Nonmydriatic fundus photograph
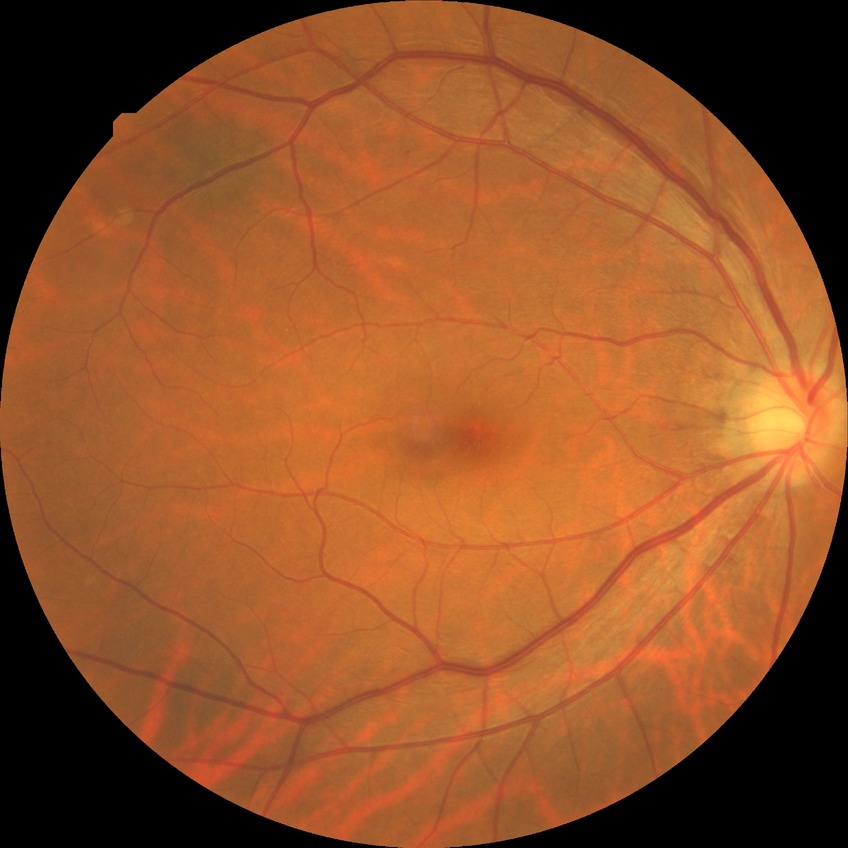

modified Davis classification: no diabetic retinopathy